Camera: NIDEK AFC-230, 848 by 848 pixels, retinal fundus photograph, nonmydriatic, FOV: 45 degrees
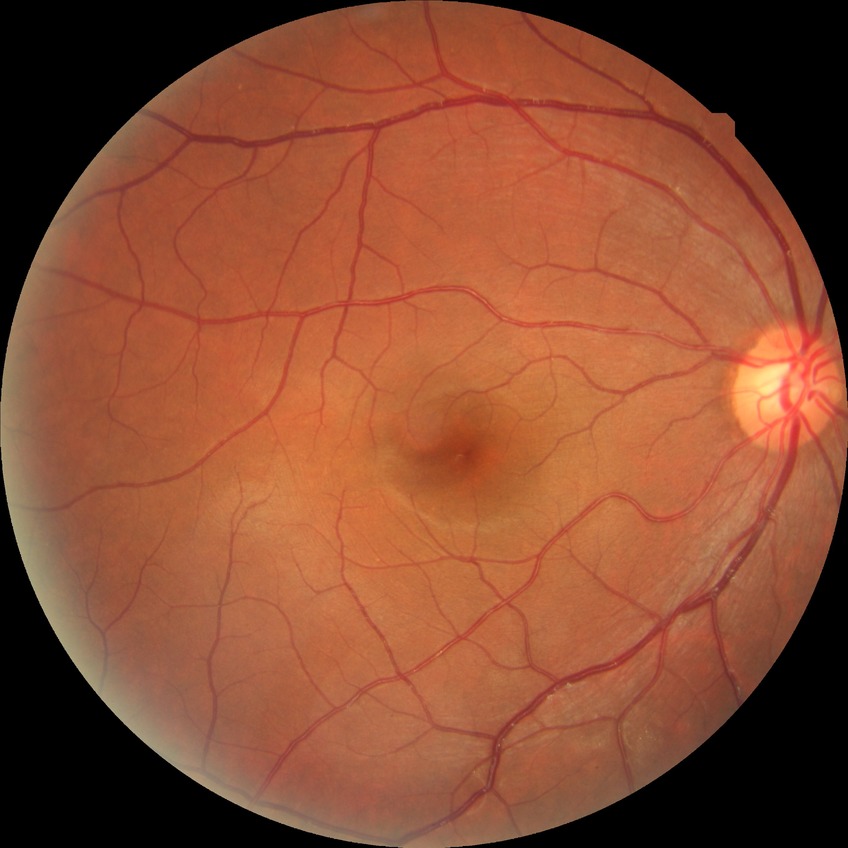 Modified Davis classification: no diabetic retinopathy.